CFP:
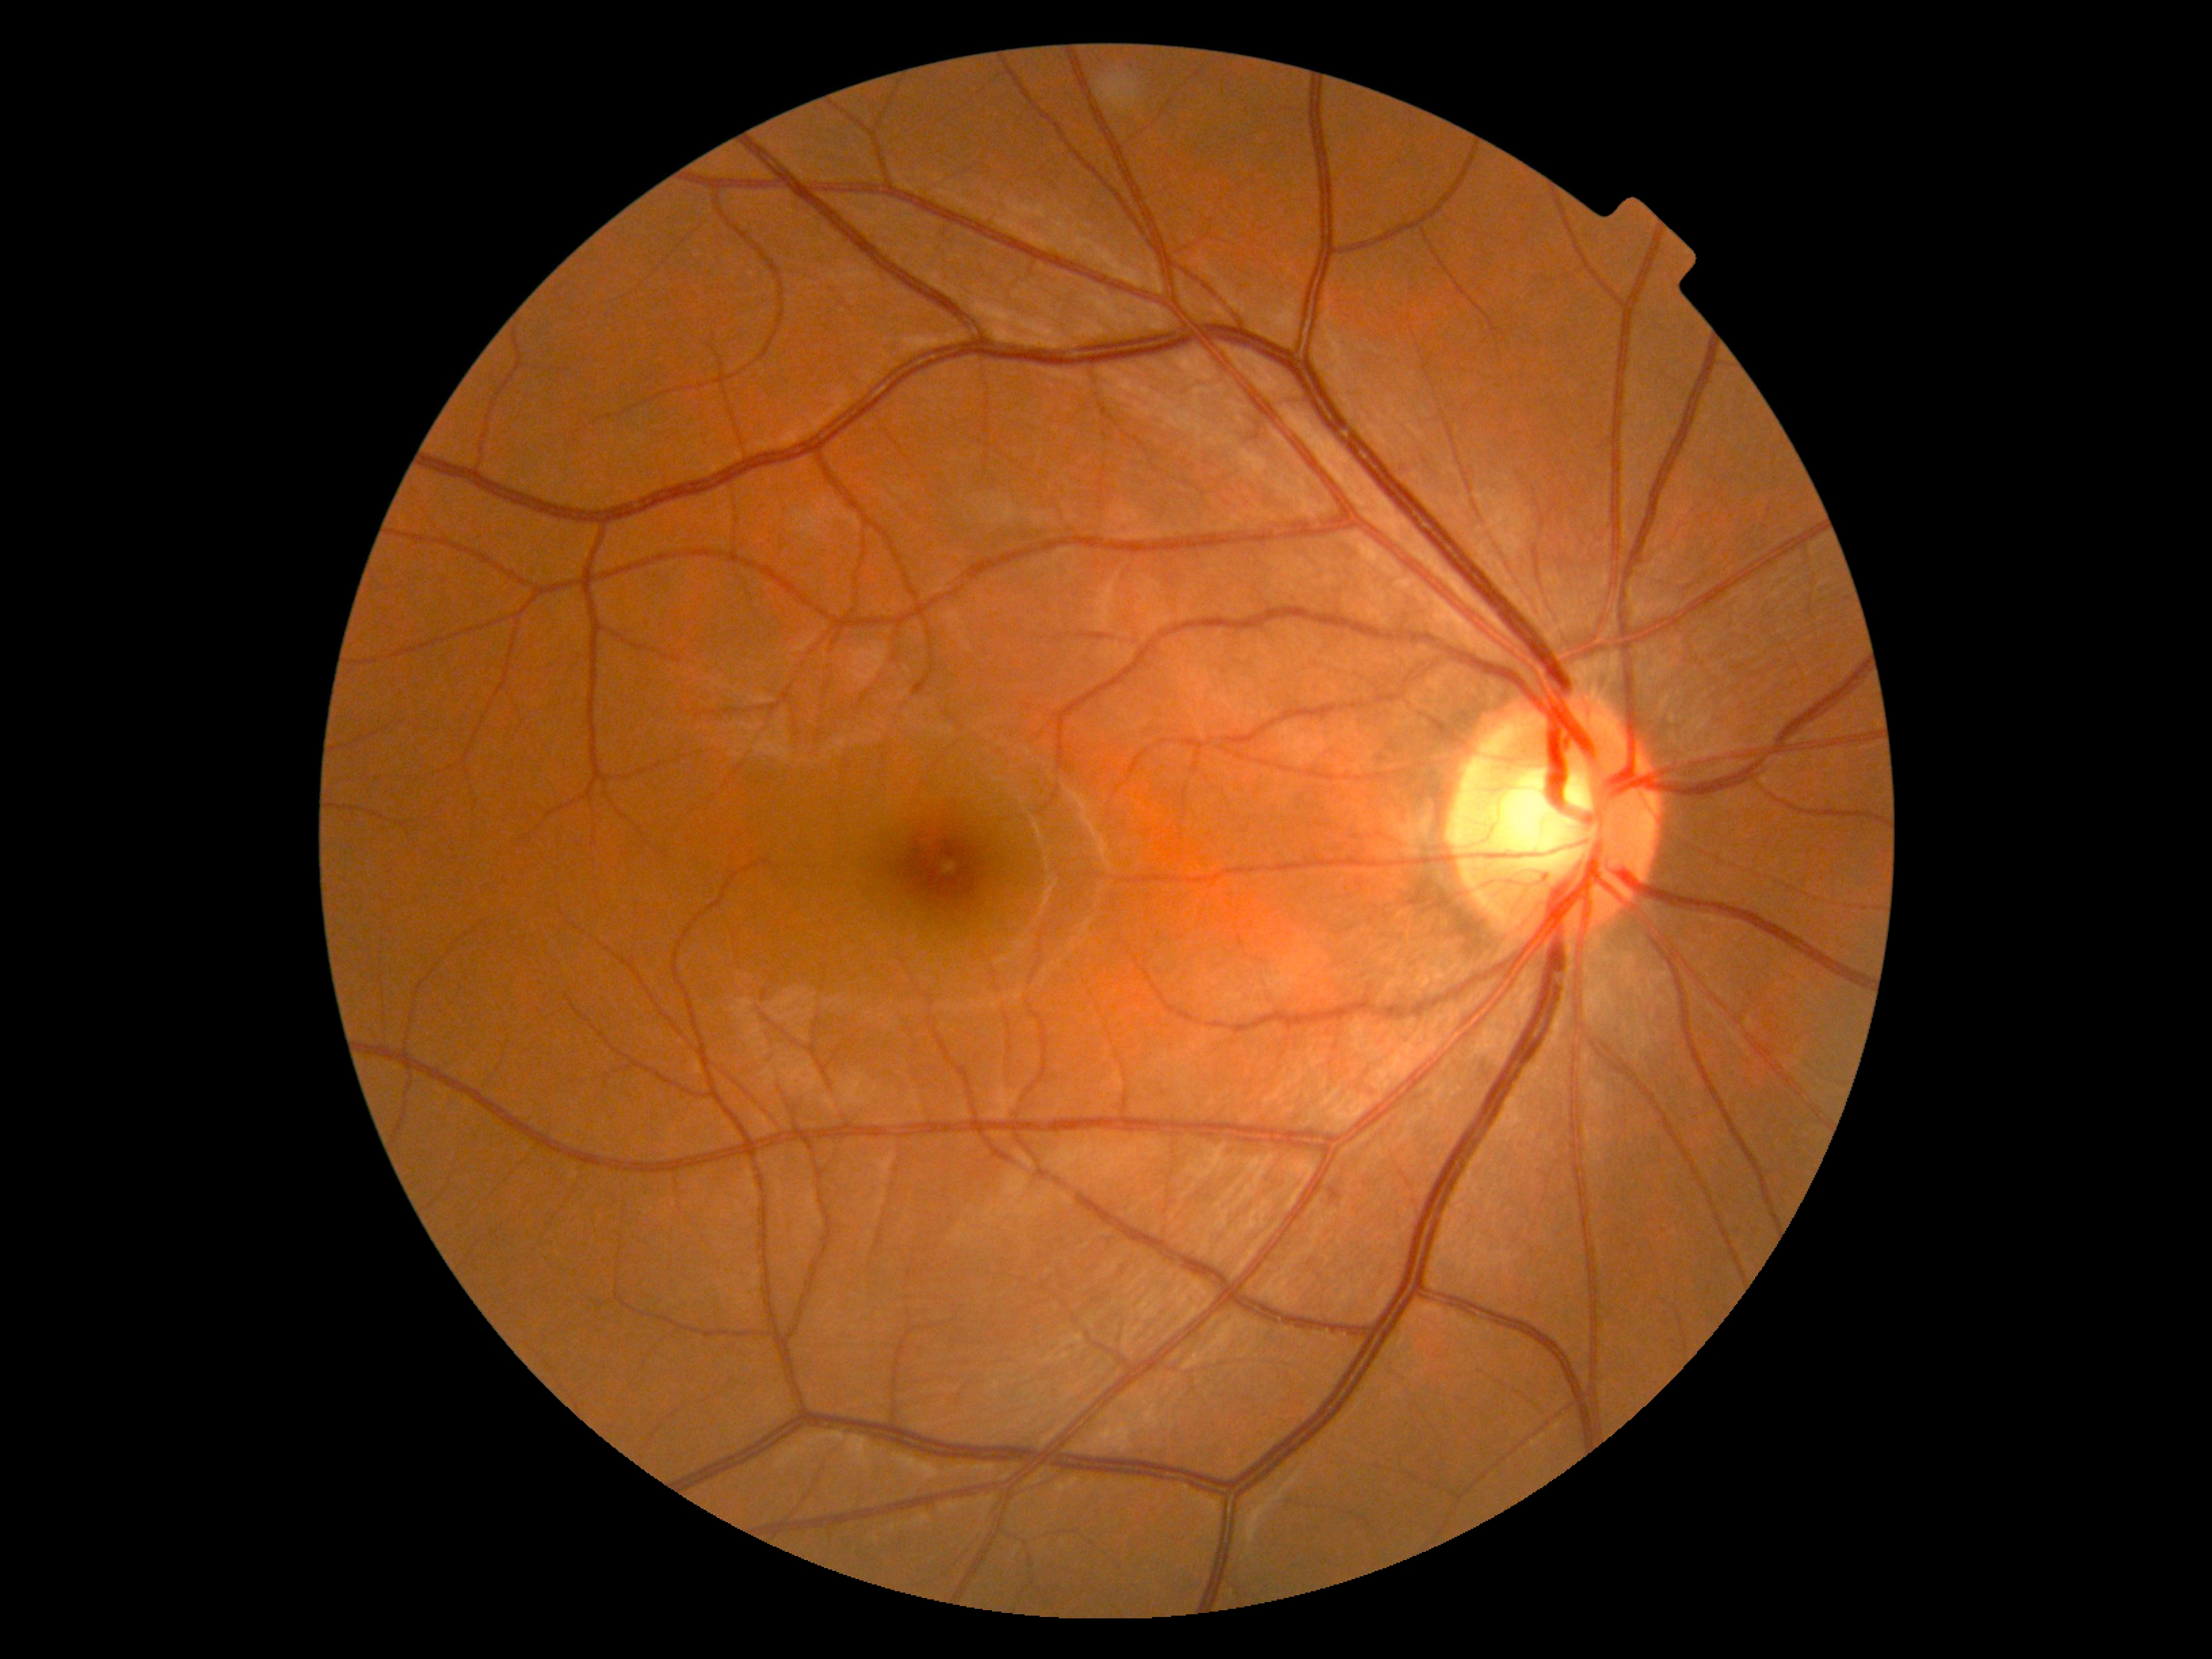
Diabetic retinopathy severity: 0 — no visible signs of diabetic retinopathy.